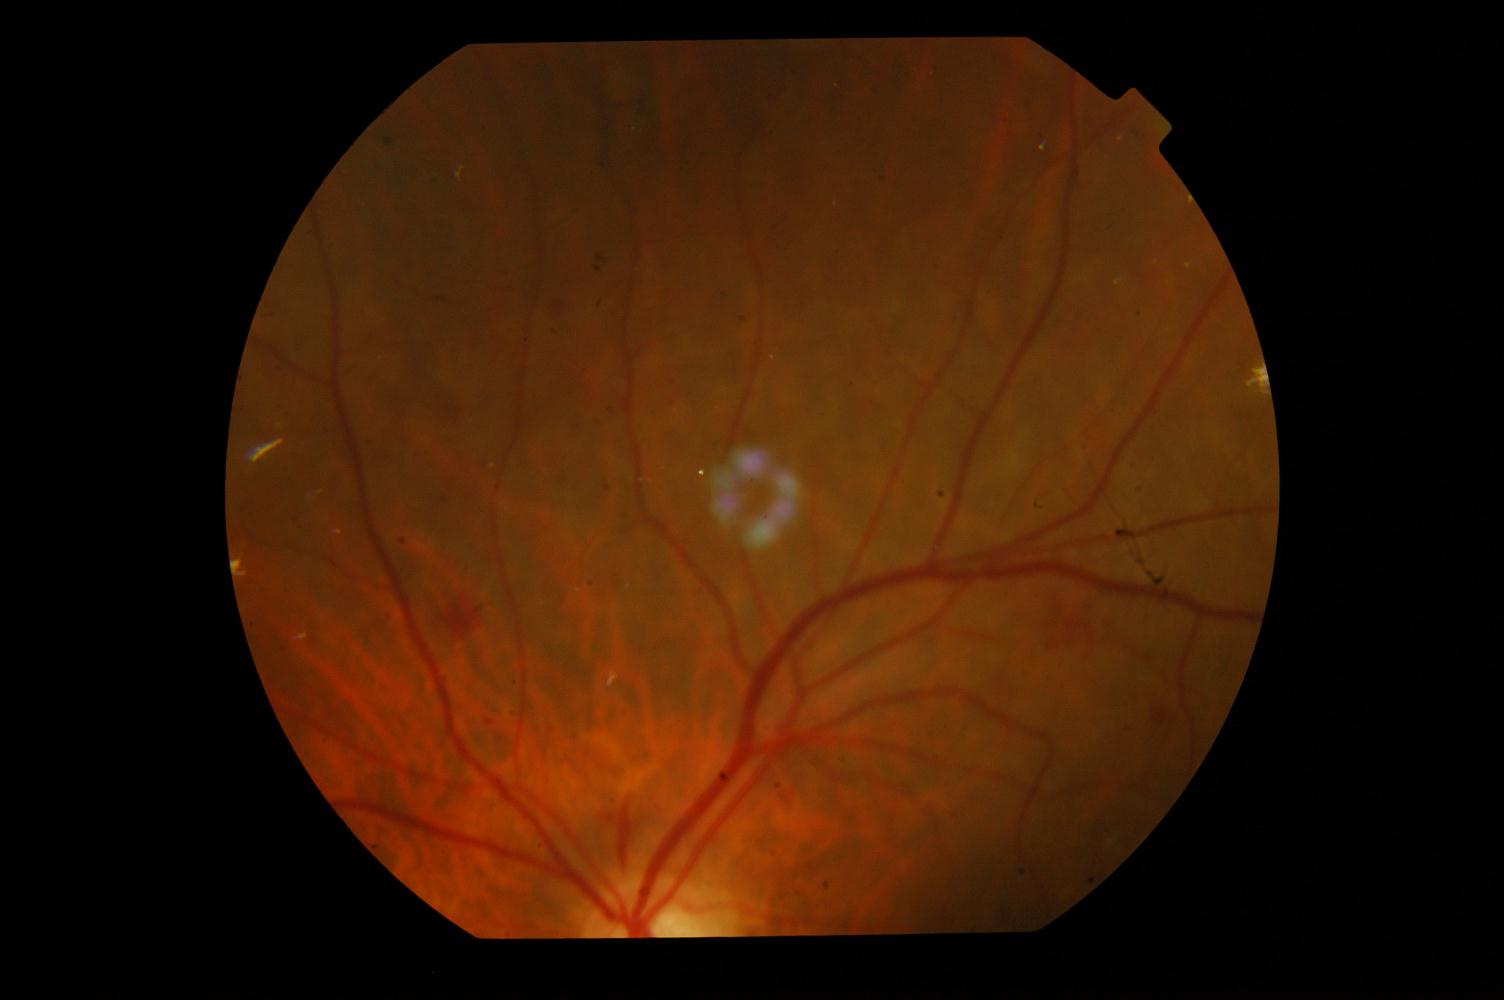 Diagnoses: diabetic retinopathy.